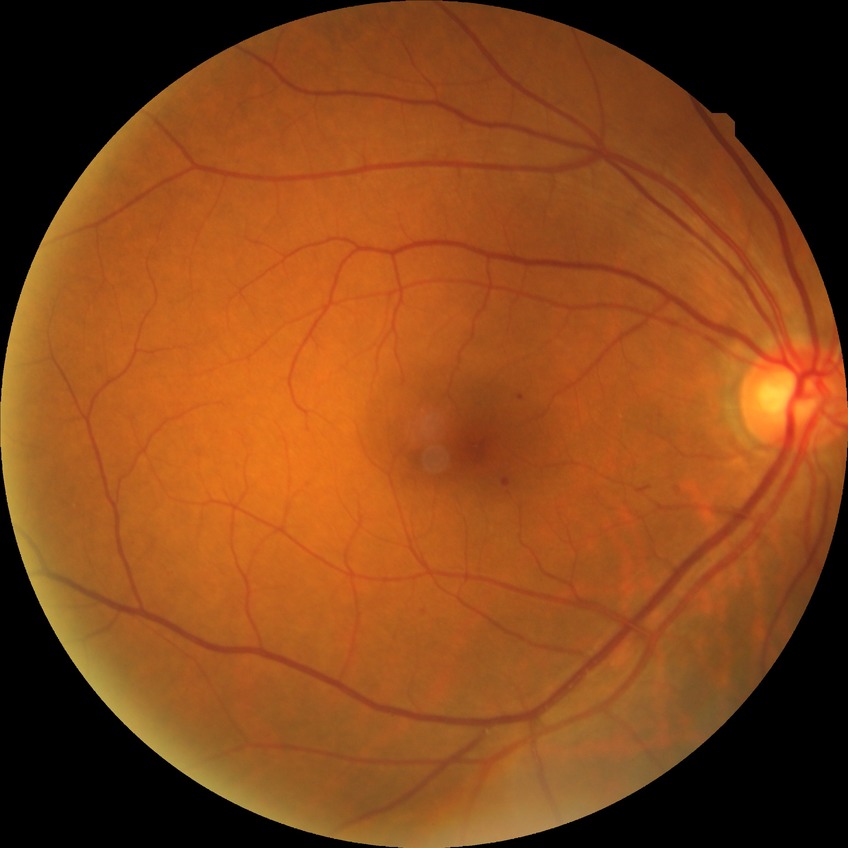
* DR severity — SDR